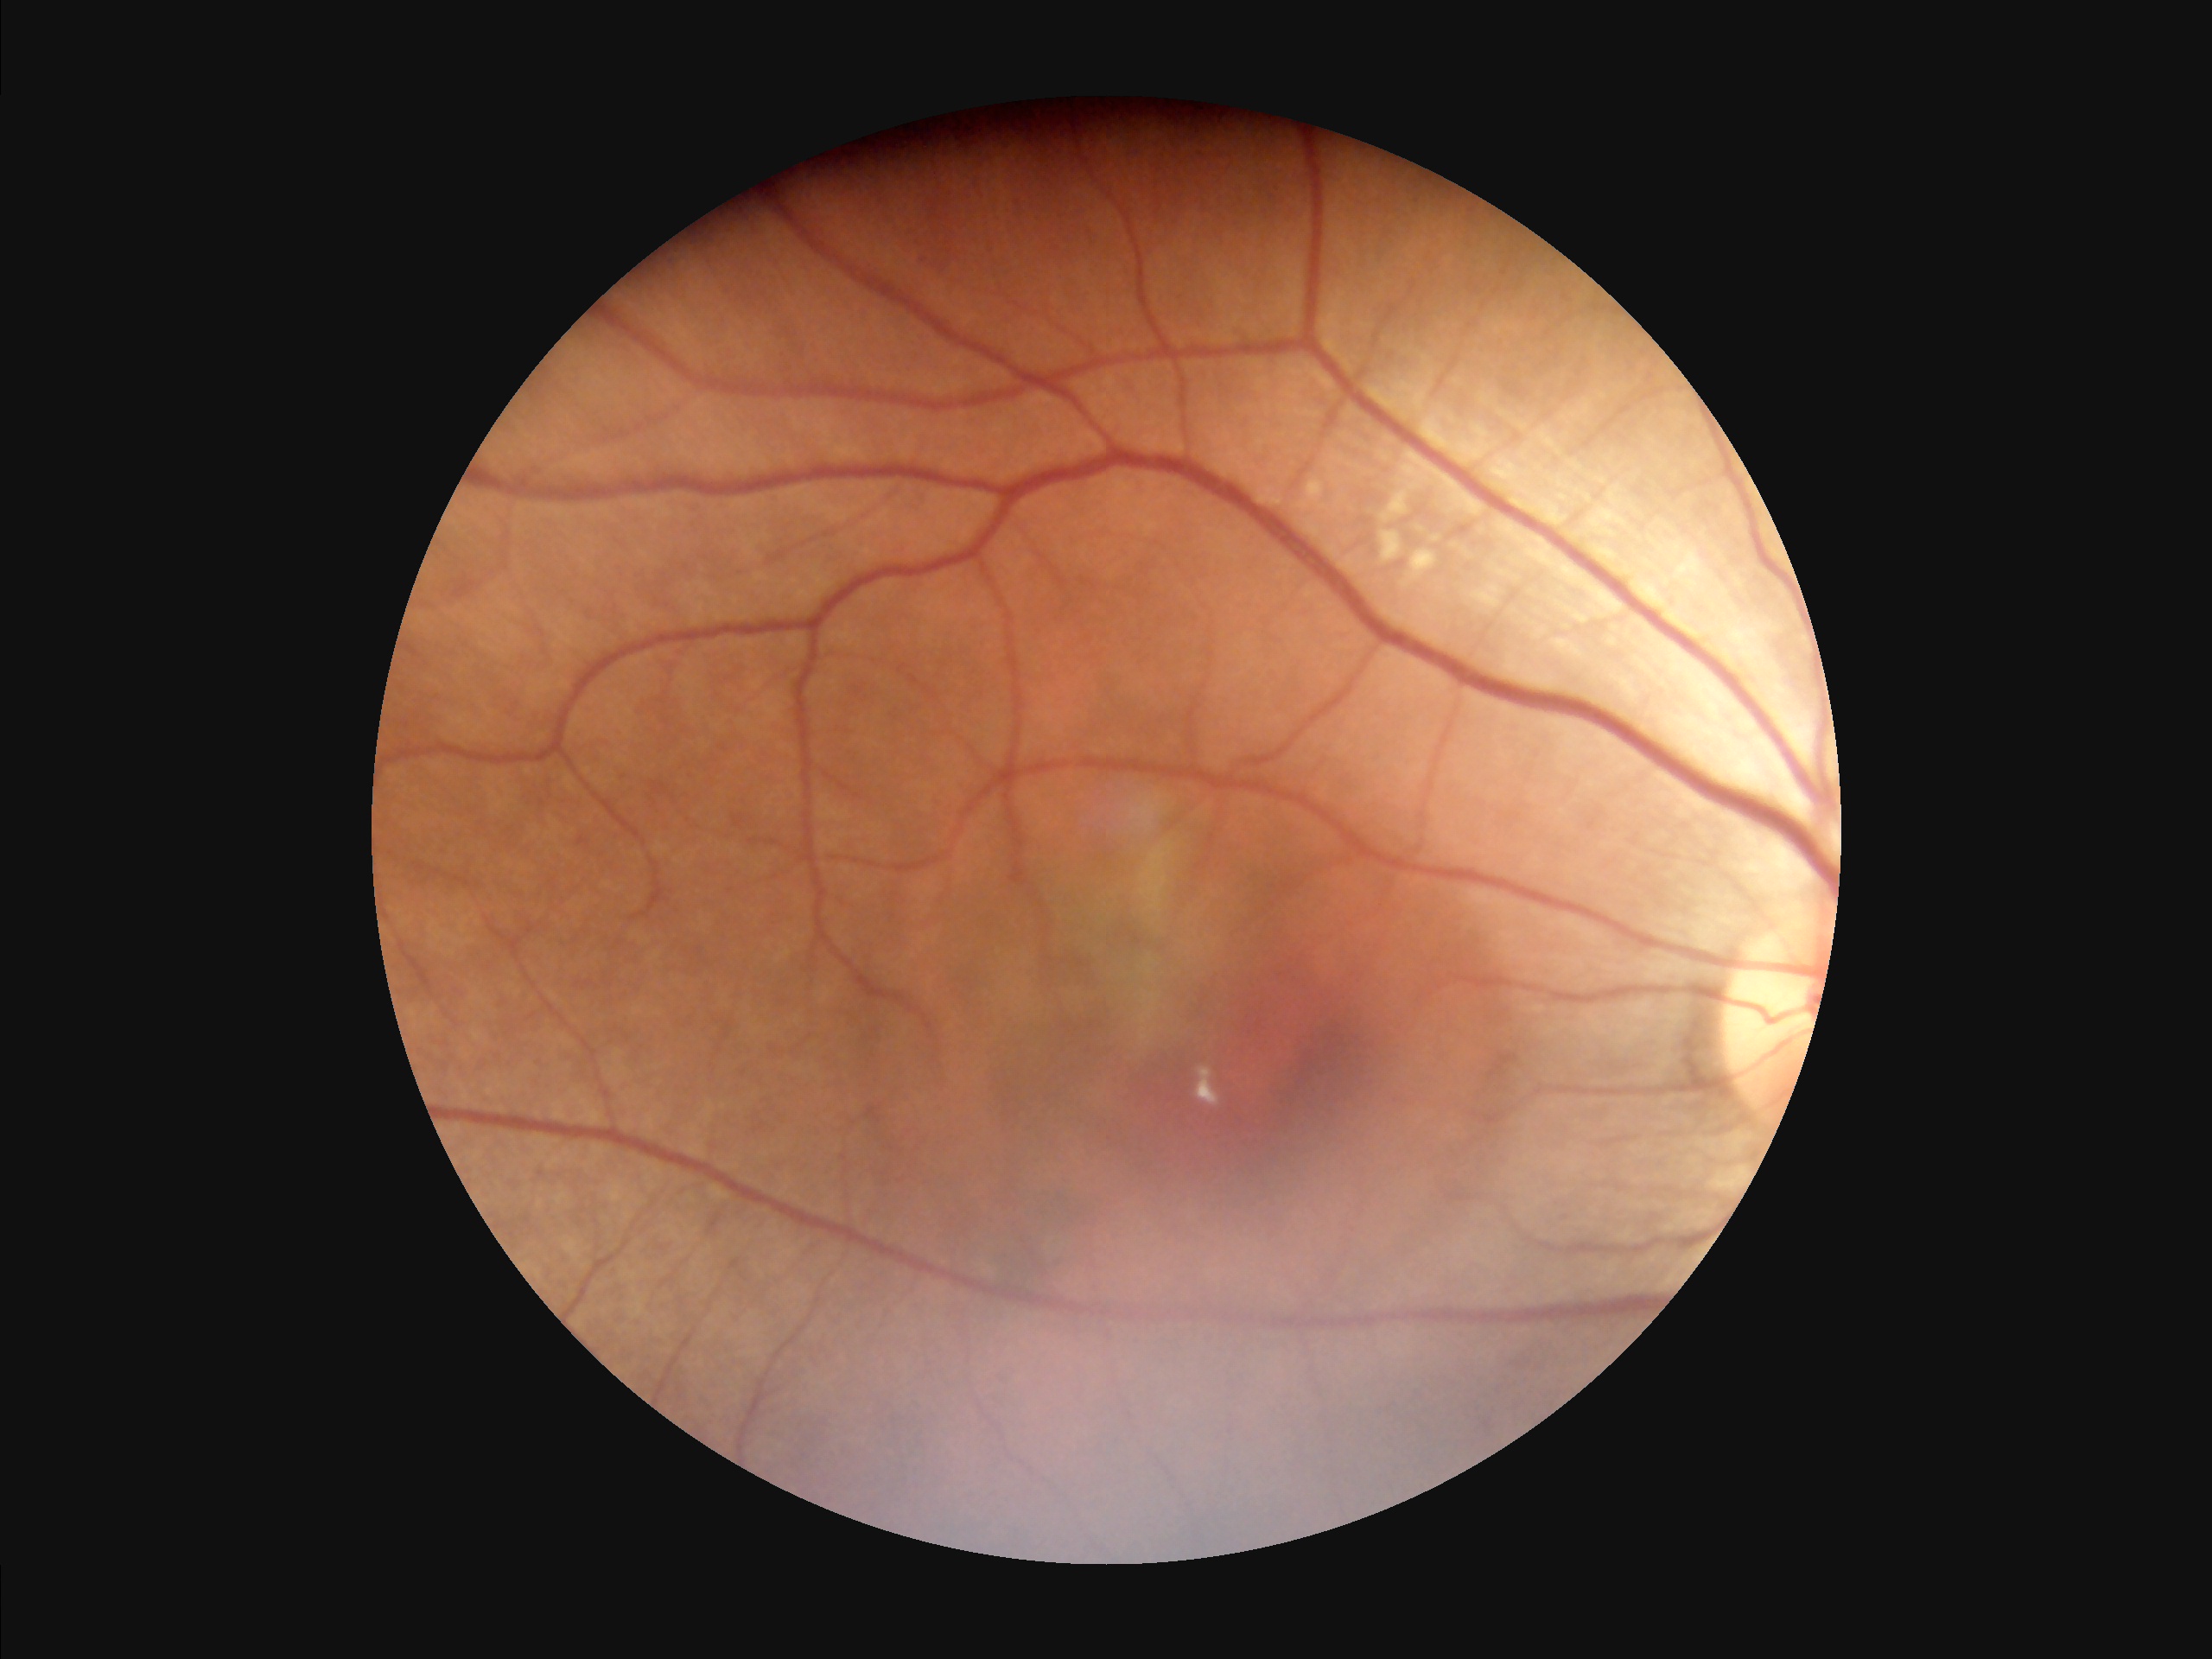

Image quality: illumination/color: good; contrast: adequate; clarity: good; overall: adequate.